Wide-field contact fundus photograph of an infant. 1240 x 1240 pixels
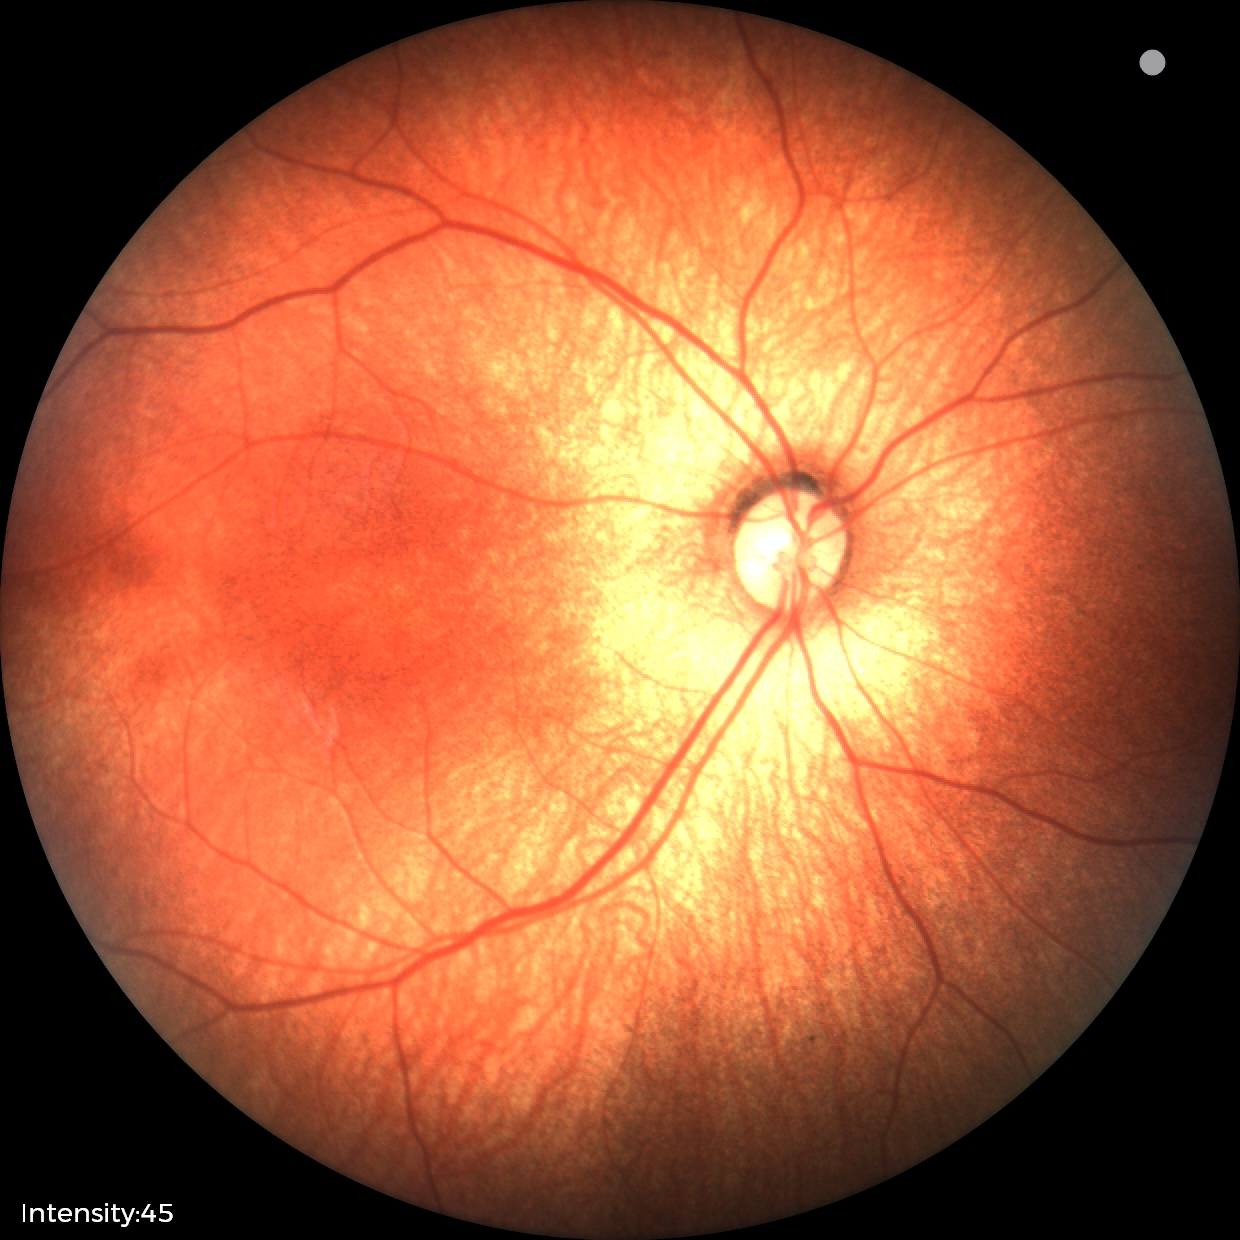 Screening examination with no abnormal retinal findings.